Modified Davis classification · acquired with a NIDEK AFC-230
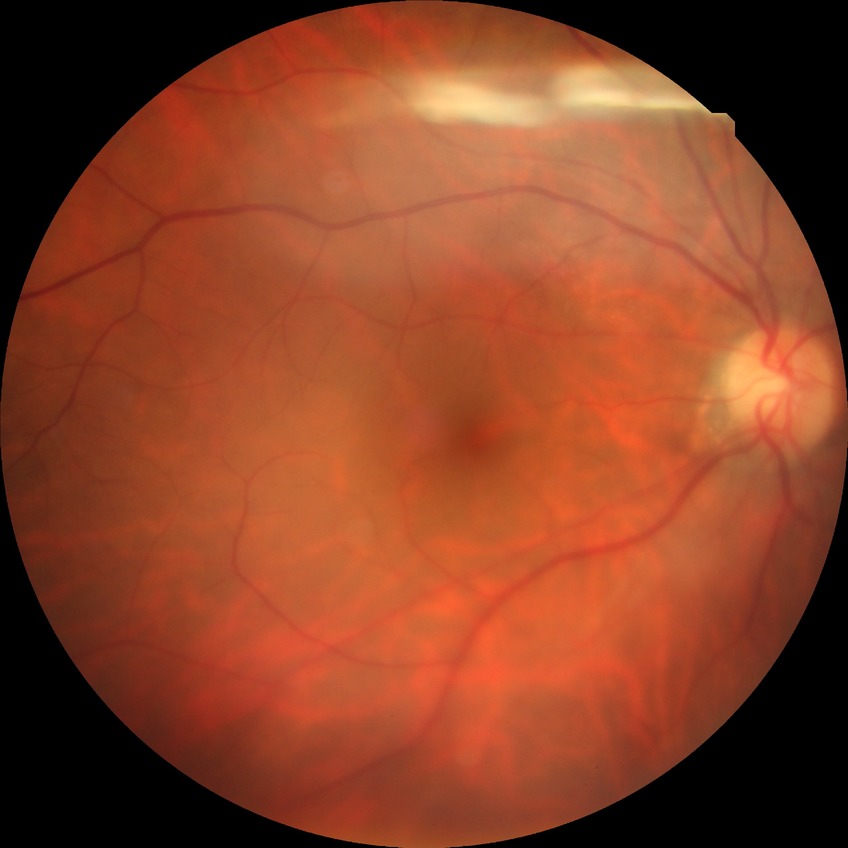 Retinopathy stage: no diabetic retinopathy.